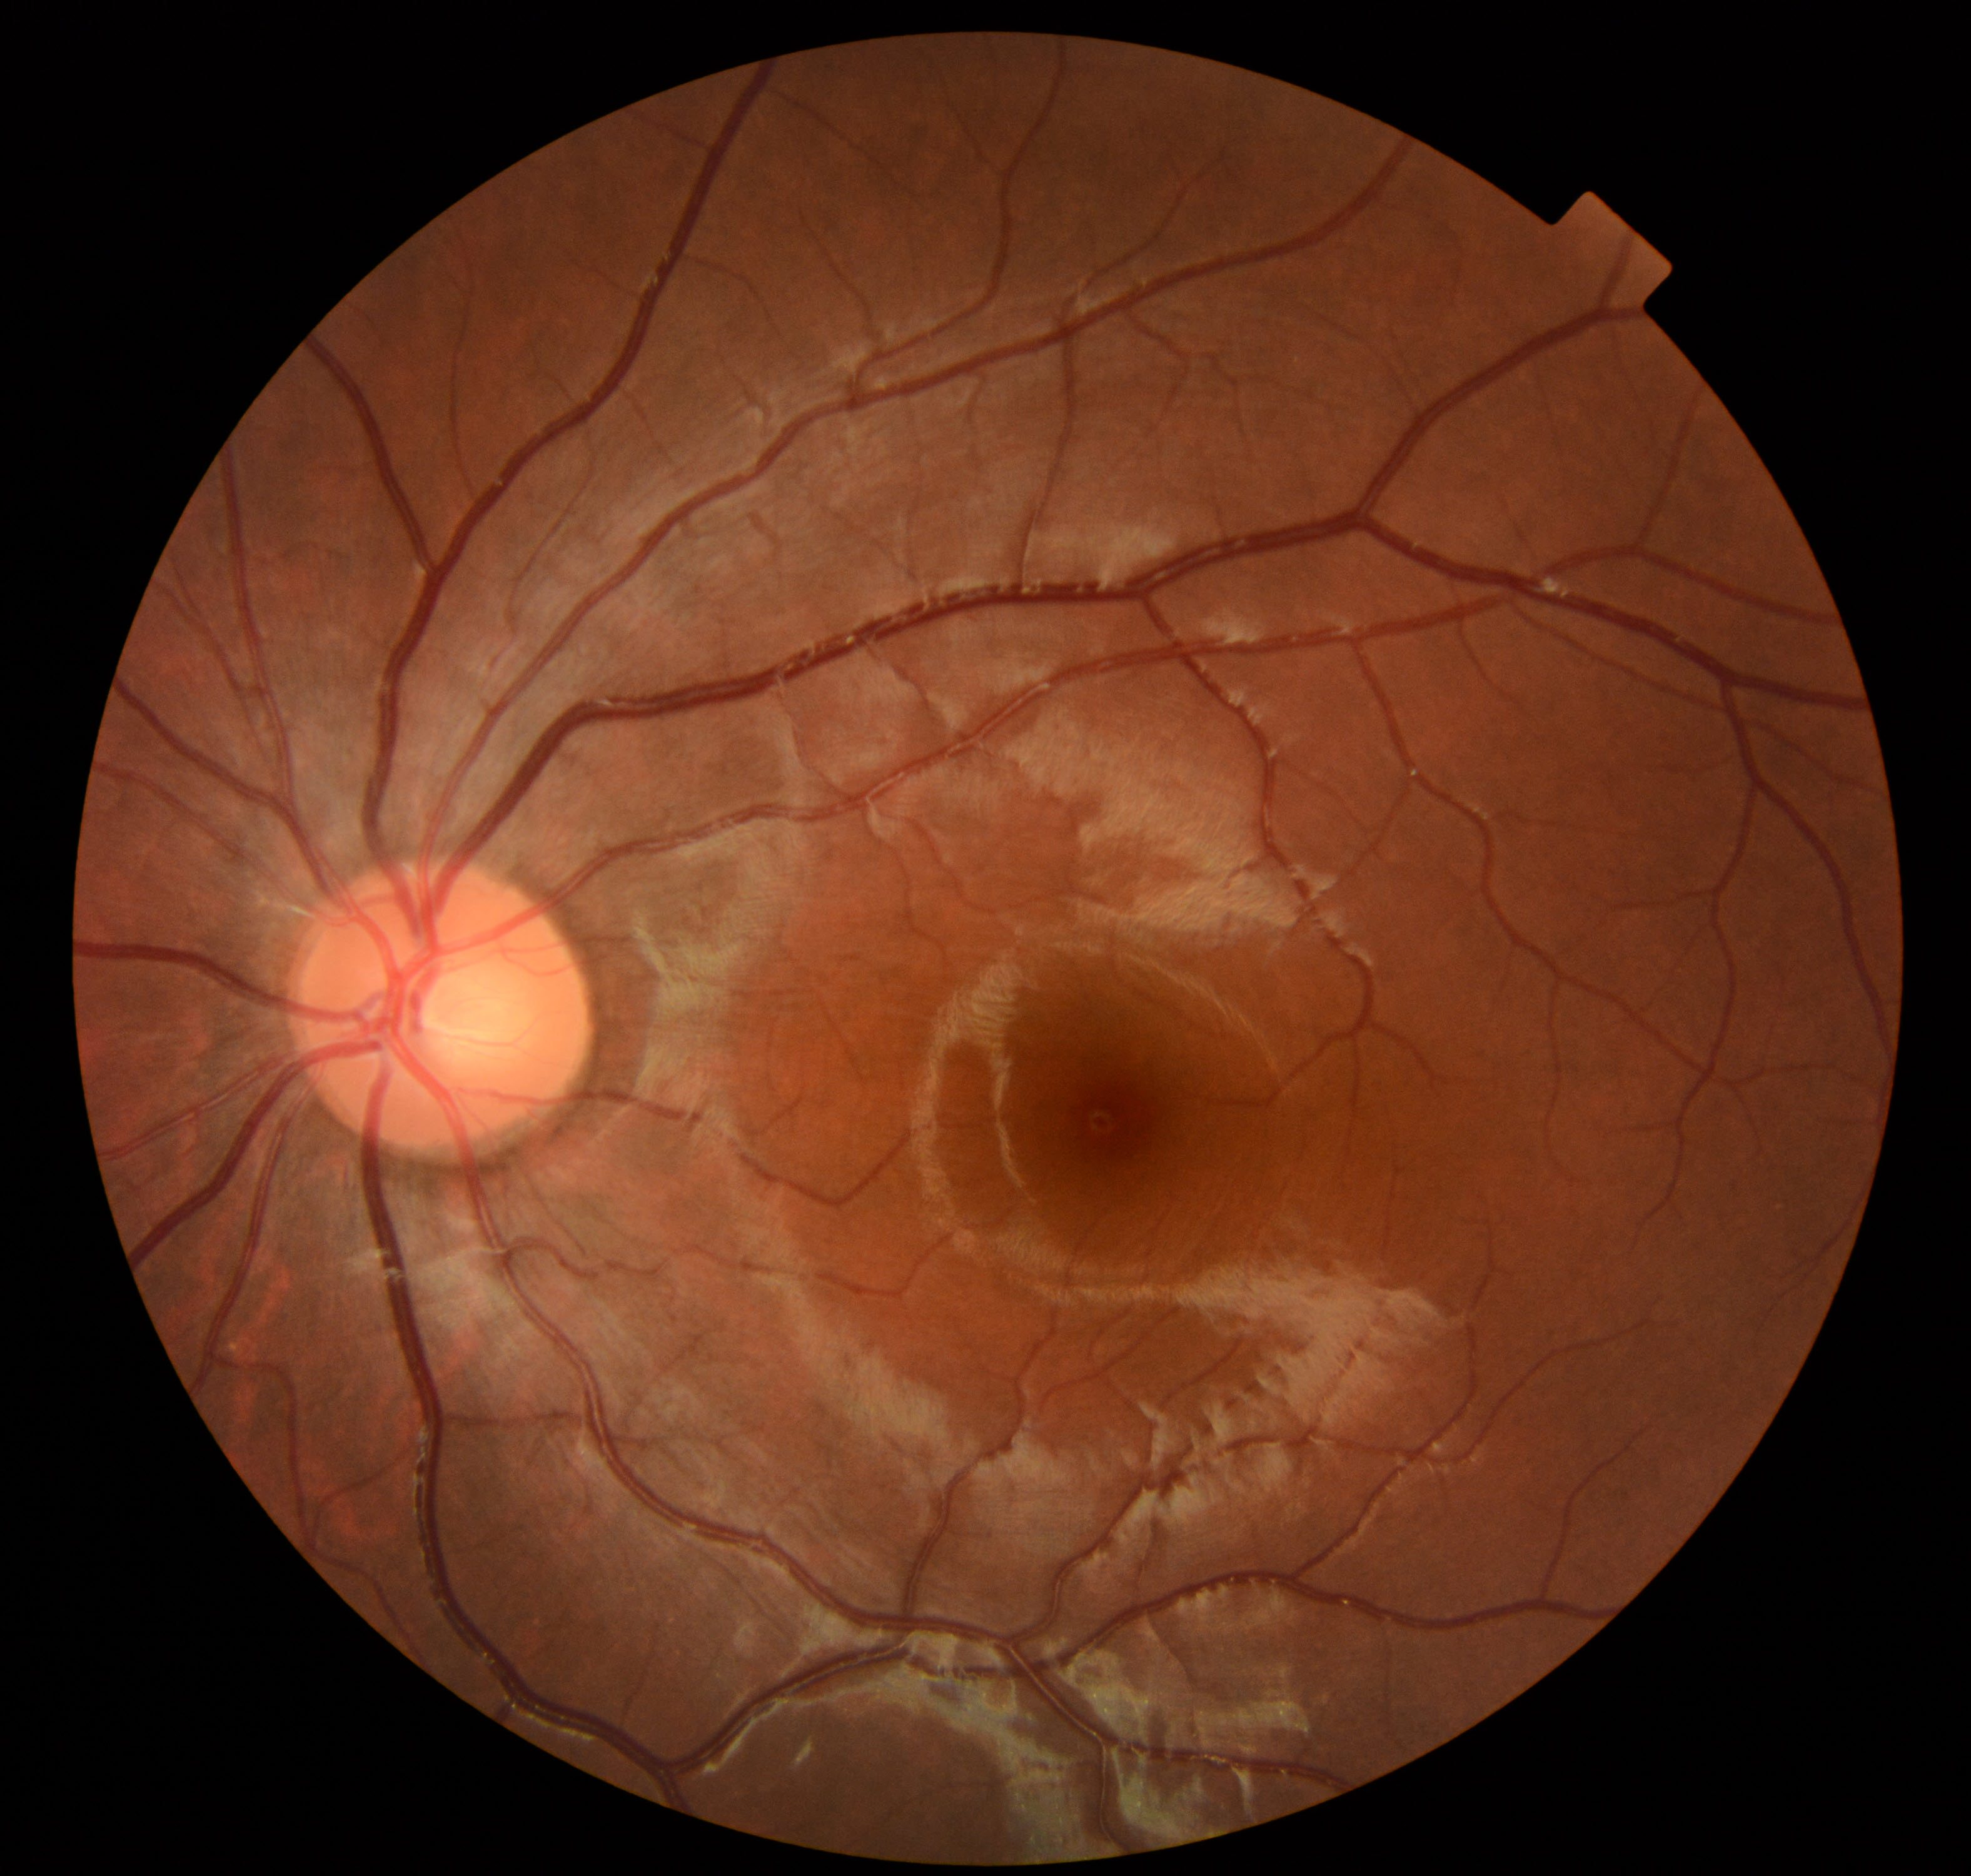
Normal fundus. No pathology identified.